Color fundus photograph
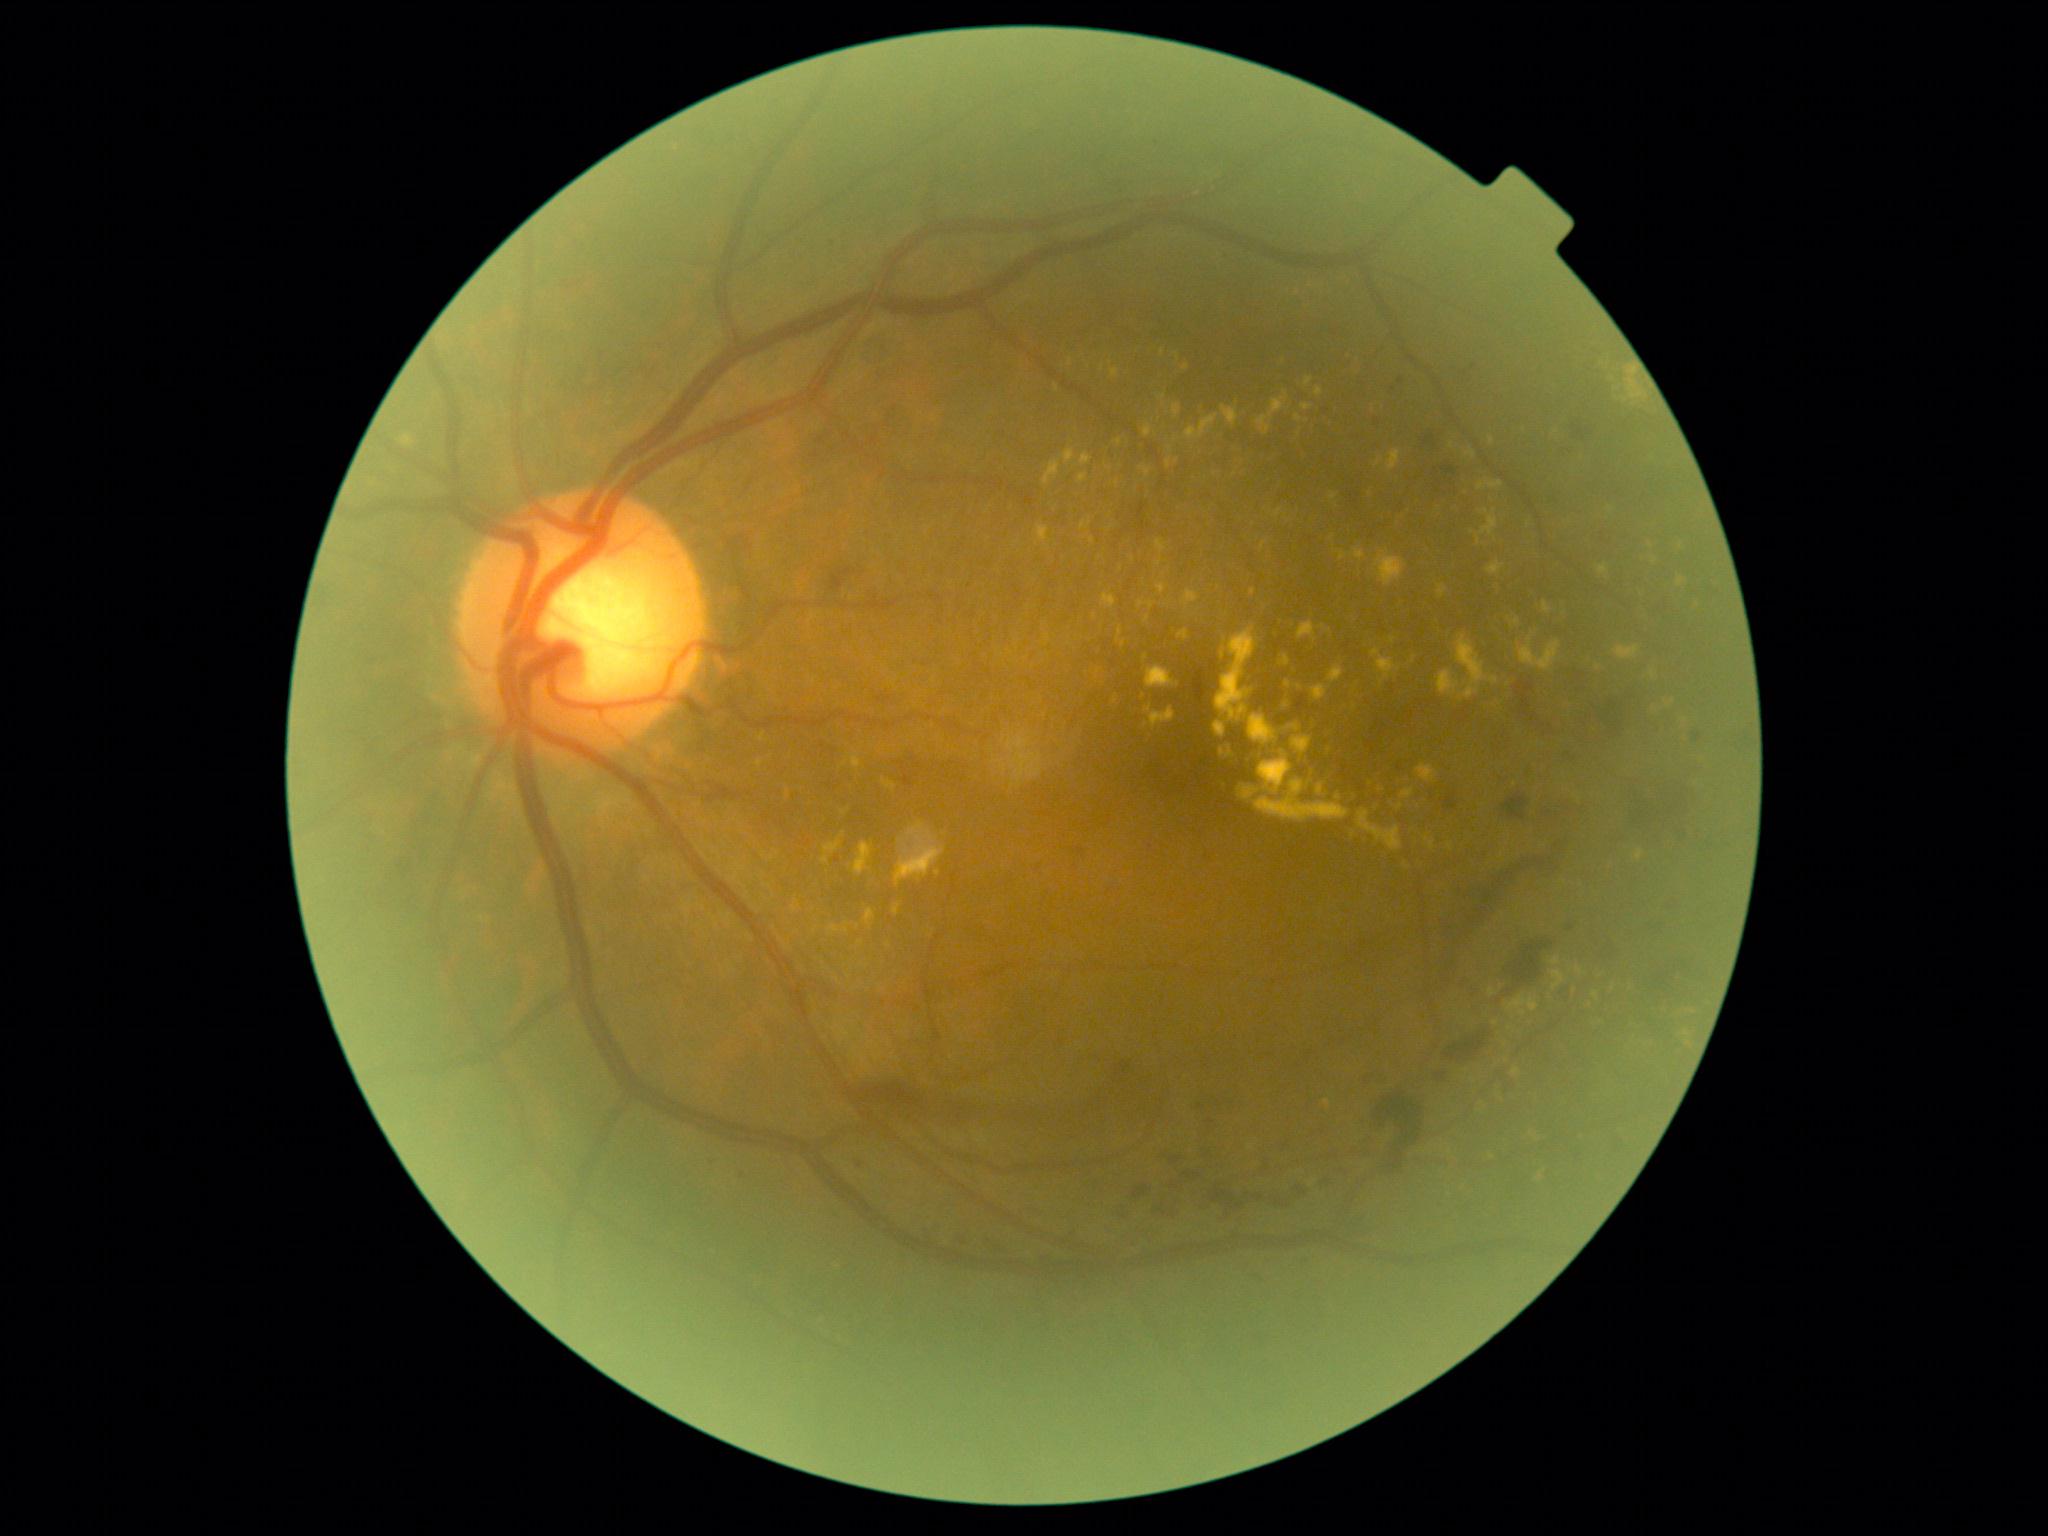

Diabetic retinopathy (DR): moderate non-proliferative diabetic retinopathy (grade 2)
A subset of detected lesions:
hemorrhages (HEs) (continued): [x1=1321, y1=1179, x2=1334, y2=1189] | [x1=1133, y1=1184, x2=1152, y2=1199] | [x1=1365, y1=1076, x2=1396, y2=1086] | [x1=1170, y1=1157, x2=1182, y2=1166] | [x1=1156, y1=1183, x2=1179, y2=1219] | [x1=1192, y1=668, x2=1211, y2=705] | [x1=1693, y1=733, x2=1702, y2=743] | [x1=1183, y1=1173, x2=1192, y2=1179] | [x1=1209, y1=1186, x2=1240, y2=1225] | [x1=1065, y1=847, x2=1085, y2=860] | [x1=1201, y1=1151, x2=1212, y2=1167] | [x1=1443, y1=1031, x2=1488, y2=1062] | [x1=1386, y1=1156, x2=1410, y2=1179] | [x1=1572, y1=425, x2=1592, y2=441] | [x1=1377, y1=1094, x2=1423, y2=1147] | [x1=1117, y1=1062, x2=1131, y2=1076] | [x1=1276, y1=1200, x2=1289, y2=1209] | [x1=1490, y1=933, x2=1550, y2=1014]
hard exudates (EXs) (continued): [x1=1401, y1=789, x2=1414, y2=799] | [x1=1256, y1=780, x2=1349, y2=822] | [x1=1185, y1=415, x2=1219, y2=441] | [x1=1316, y1=785, x2=1323, y2=796] | [x1=1144, y1=425, x2=1152, y2=438] | [x1=1628, y1=367, x2=1638, y2=376] | [x1=1297, y1=621, x2=1316, y2=642] | [x1=1351, y1=549, x2=1365, y2=561] | [x1=1481, y1=510, x2=1490, y2=515] | [x1=1182, y1=591, x2=1199, y2=607] | [x1=756, y1=760, x2=765, y2=767] | [x1=1650, y1=670, x2=1656, y2=679]
EXs (small, approximate centers) near 1162:353 | 1090:524 | 845:765 | 1400:808 | 1095:617 | 1652:547 | 1146:657